Wide-field fundus photograph of an infant.
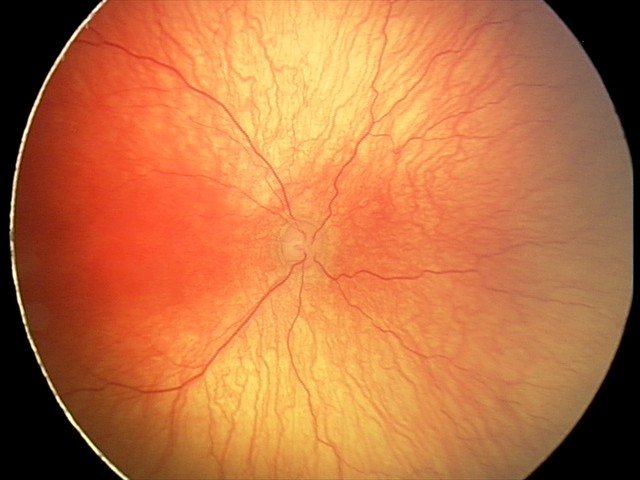
Series diagnosed as aggressive retinopathy of prematurity.